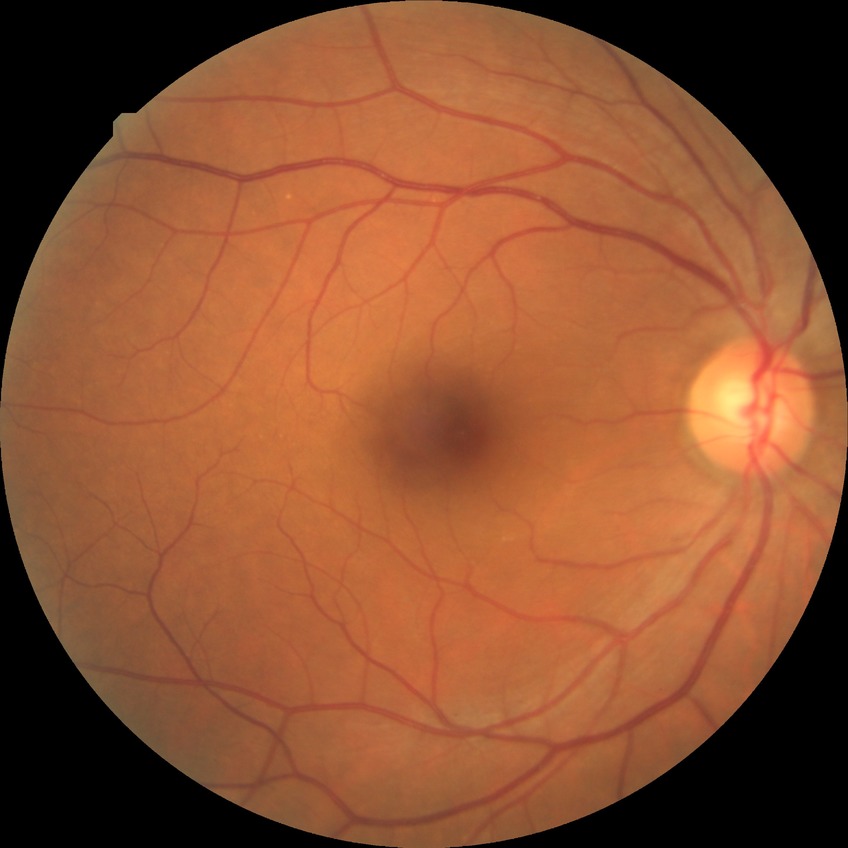 Assessment:
* diabetic retinopathy (DR): NDR (no diabetic retinopathy)